NIDEK AFC-230. Nonmydriatic. 848x848px. Color fundus photograph. 45° FOV — 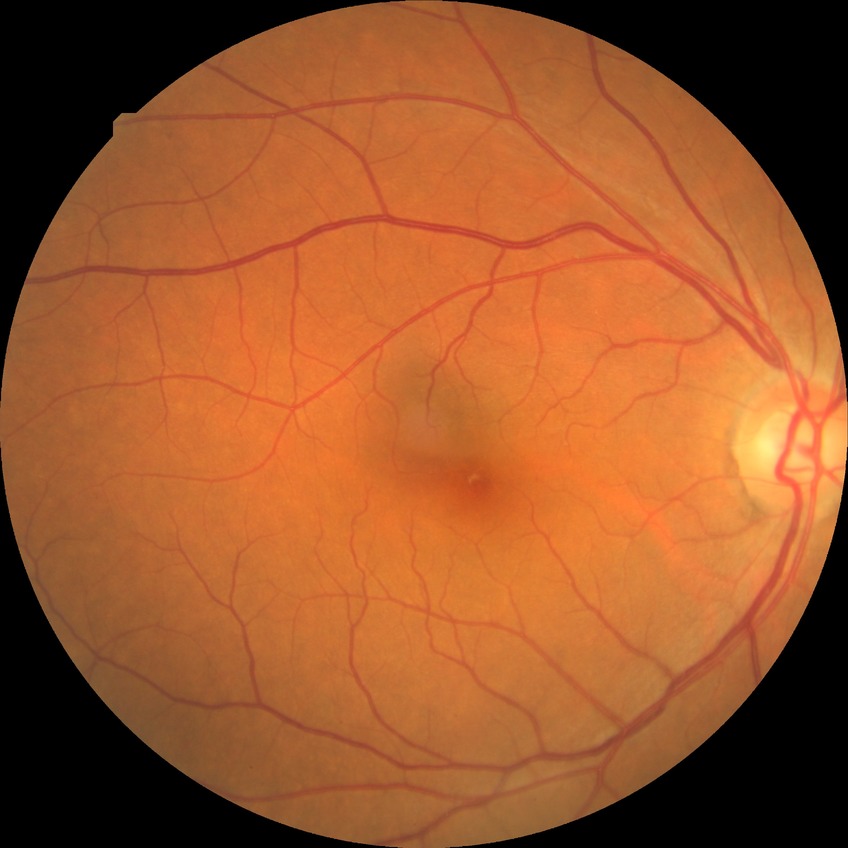

modified Davis grading = no diabetic retinopathy.